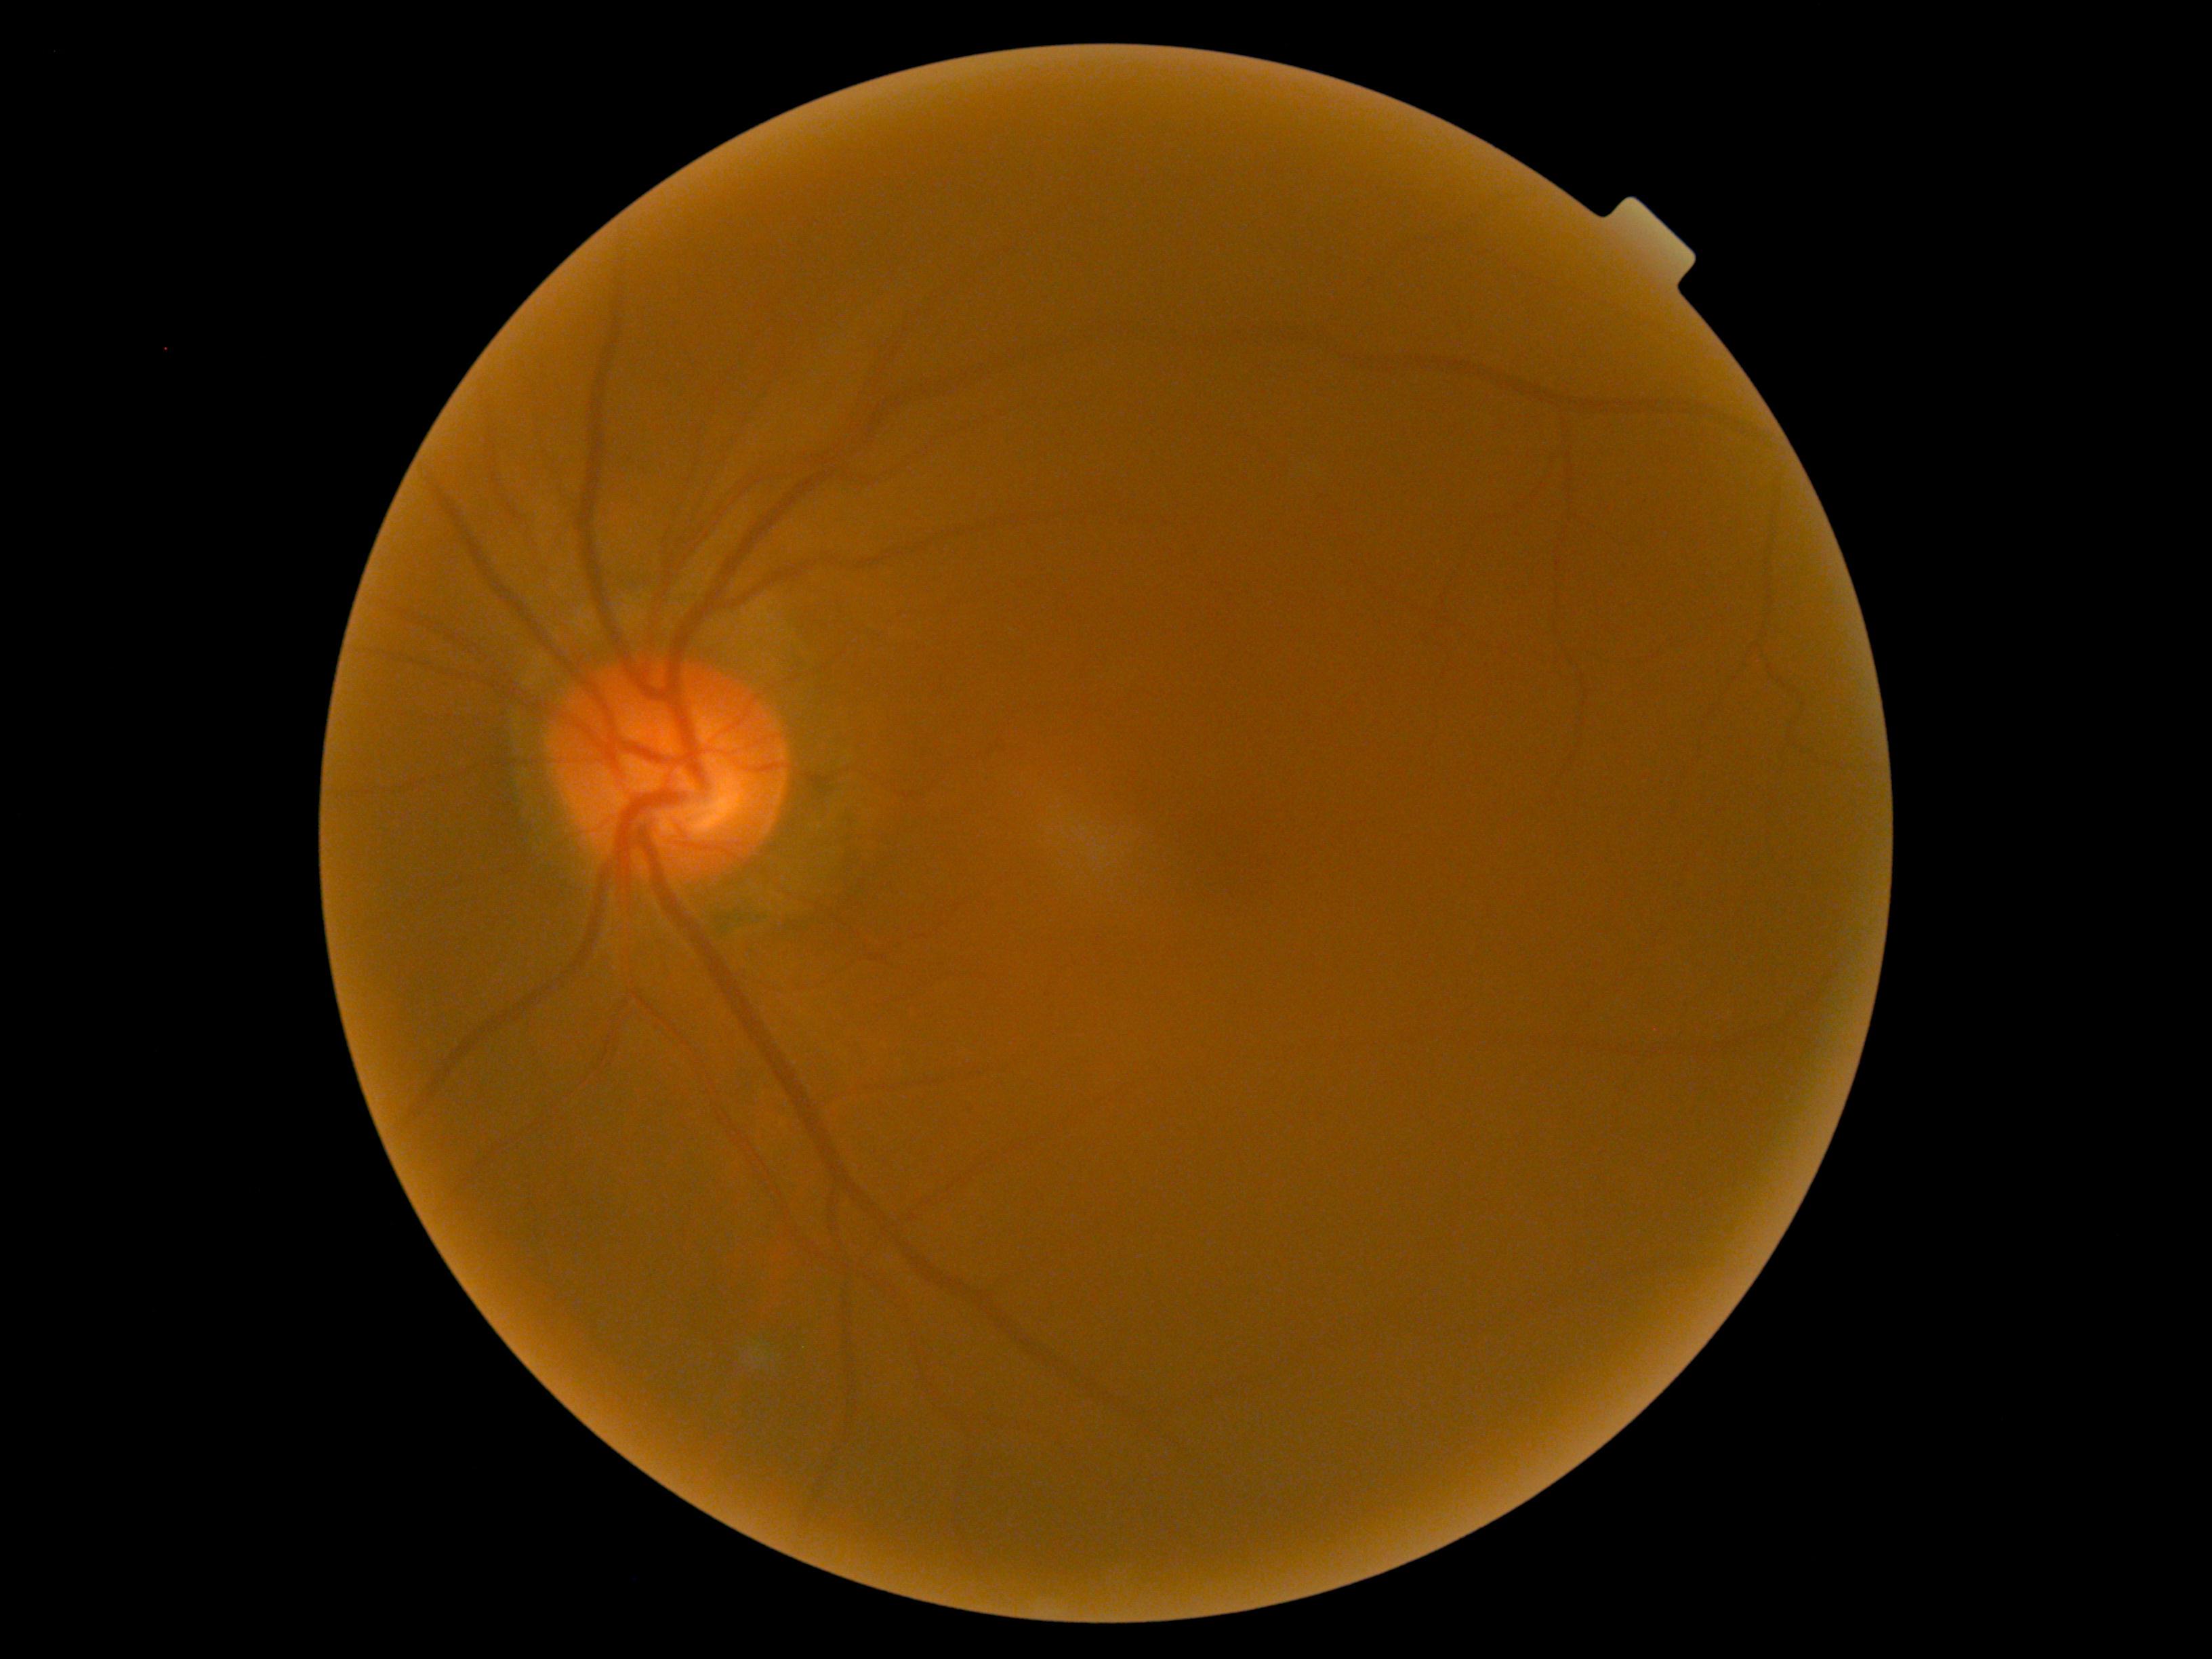

diabetic retinopathy: no apparent retinopathy (grade 0) — no visible signs of diabetic retinopathy.